1920 by 1088 pixels. Fundus photo. 45° FOV:
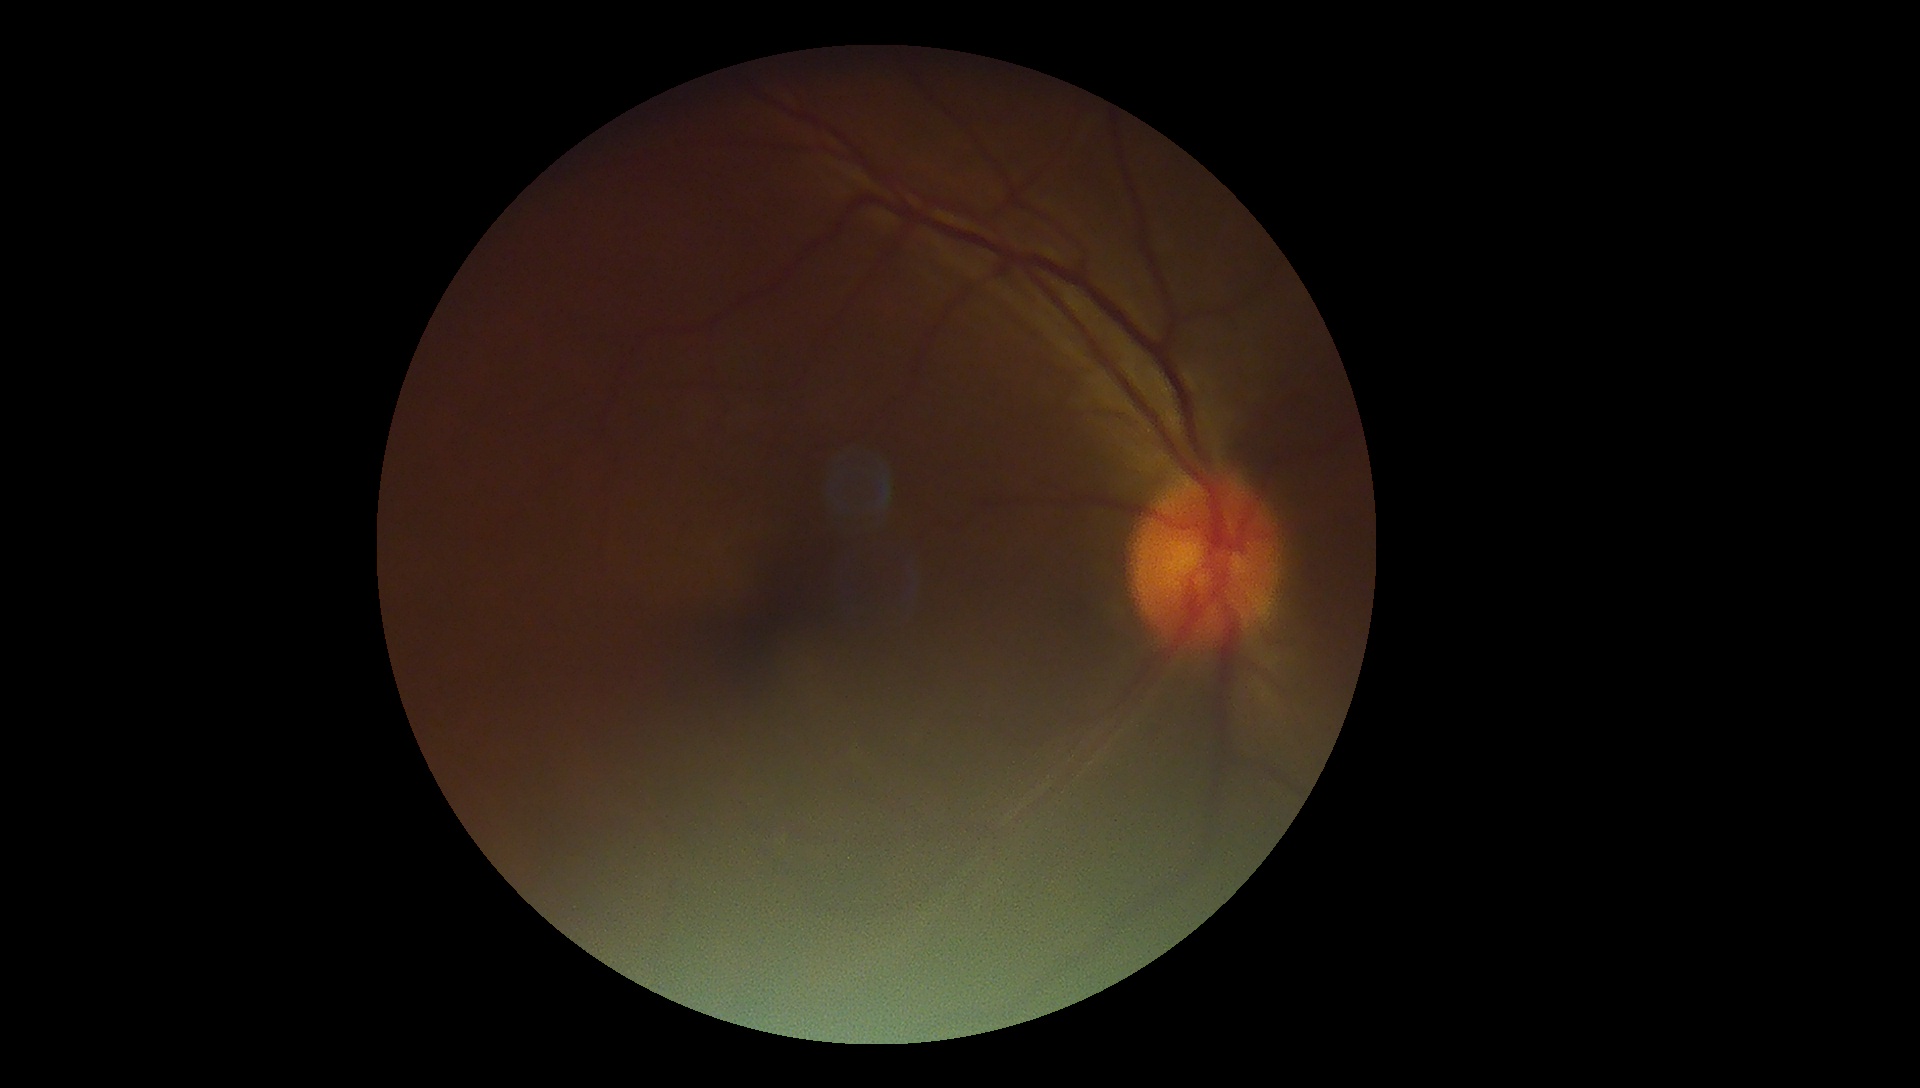
DR: no apparent retinopathy (grade 0).